45° field of view; color fundus image; image size 1515x1275: 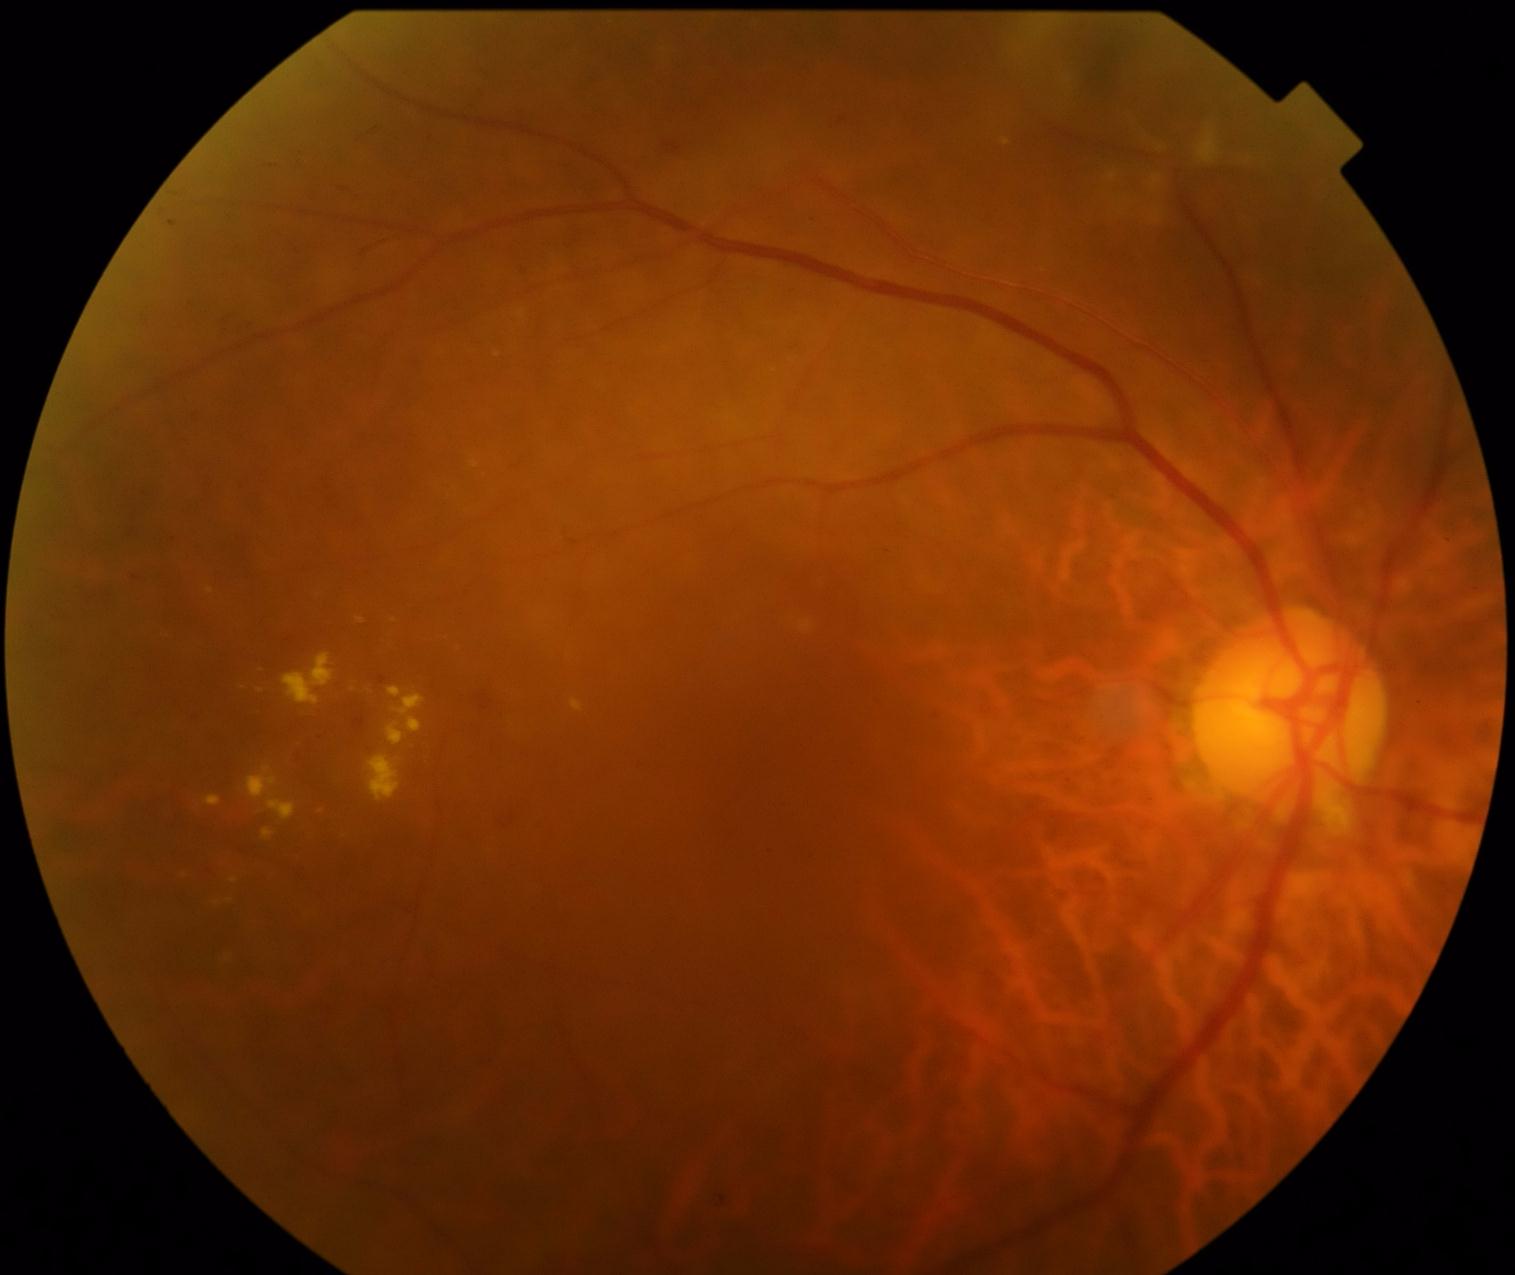

The retinopathy is classified as non-proliferative diabetic retinopathy. Diabetic retinopathy severity: grade 2 (moderate NPDR) — more than just microaneurysms but less than severe NPDR.